CFP. Modified Davis grading. NIDEK AFC-230 fundus camera. 45° FOV.
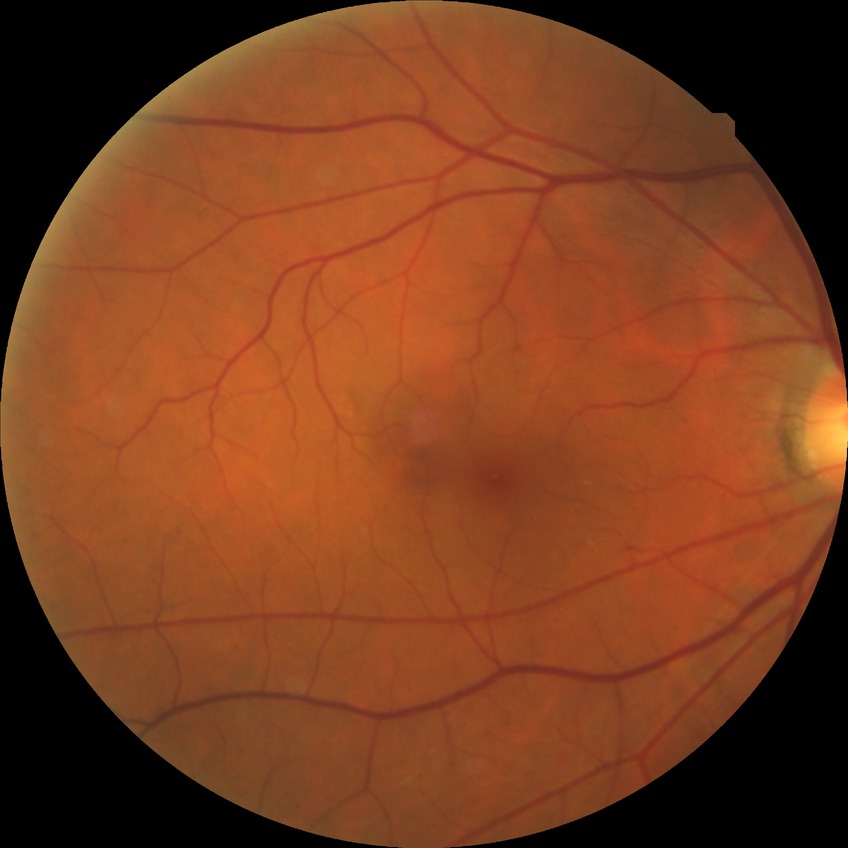

{
  "davis_grade": "no diabetic retinopathy"
}